2352x1568; color fundus photograph: 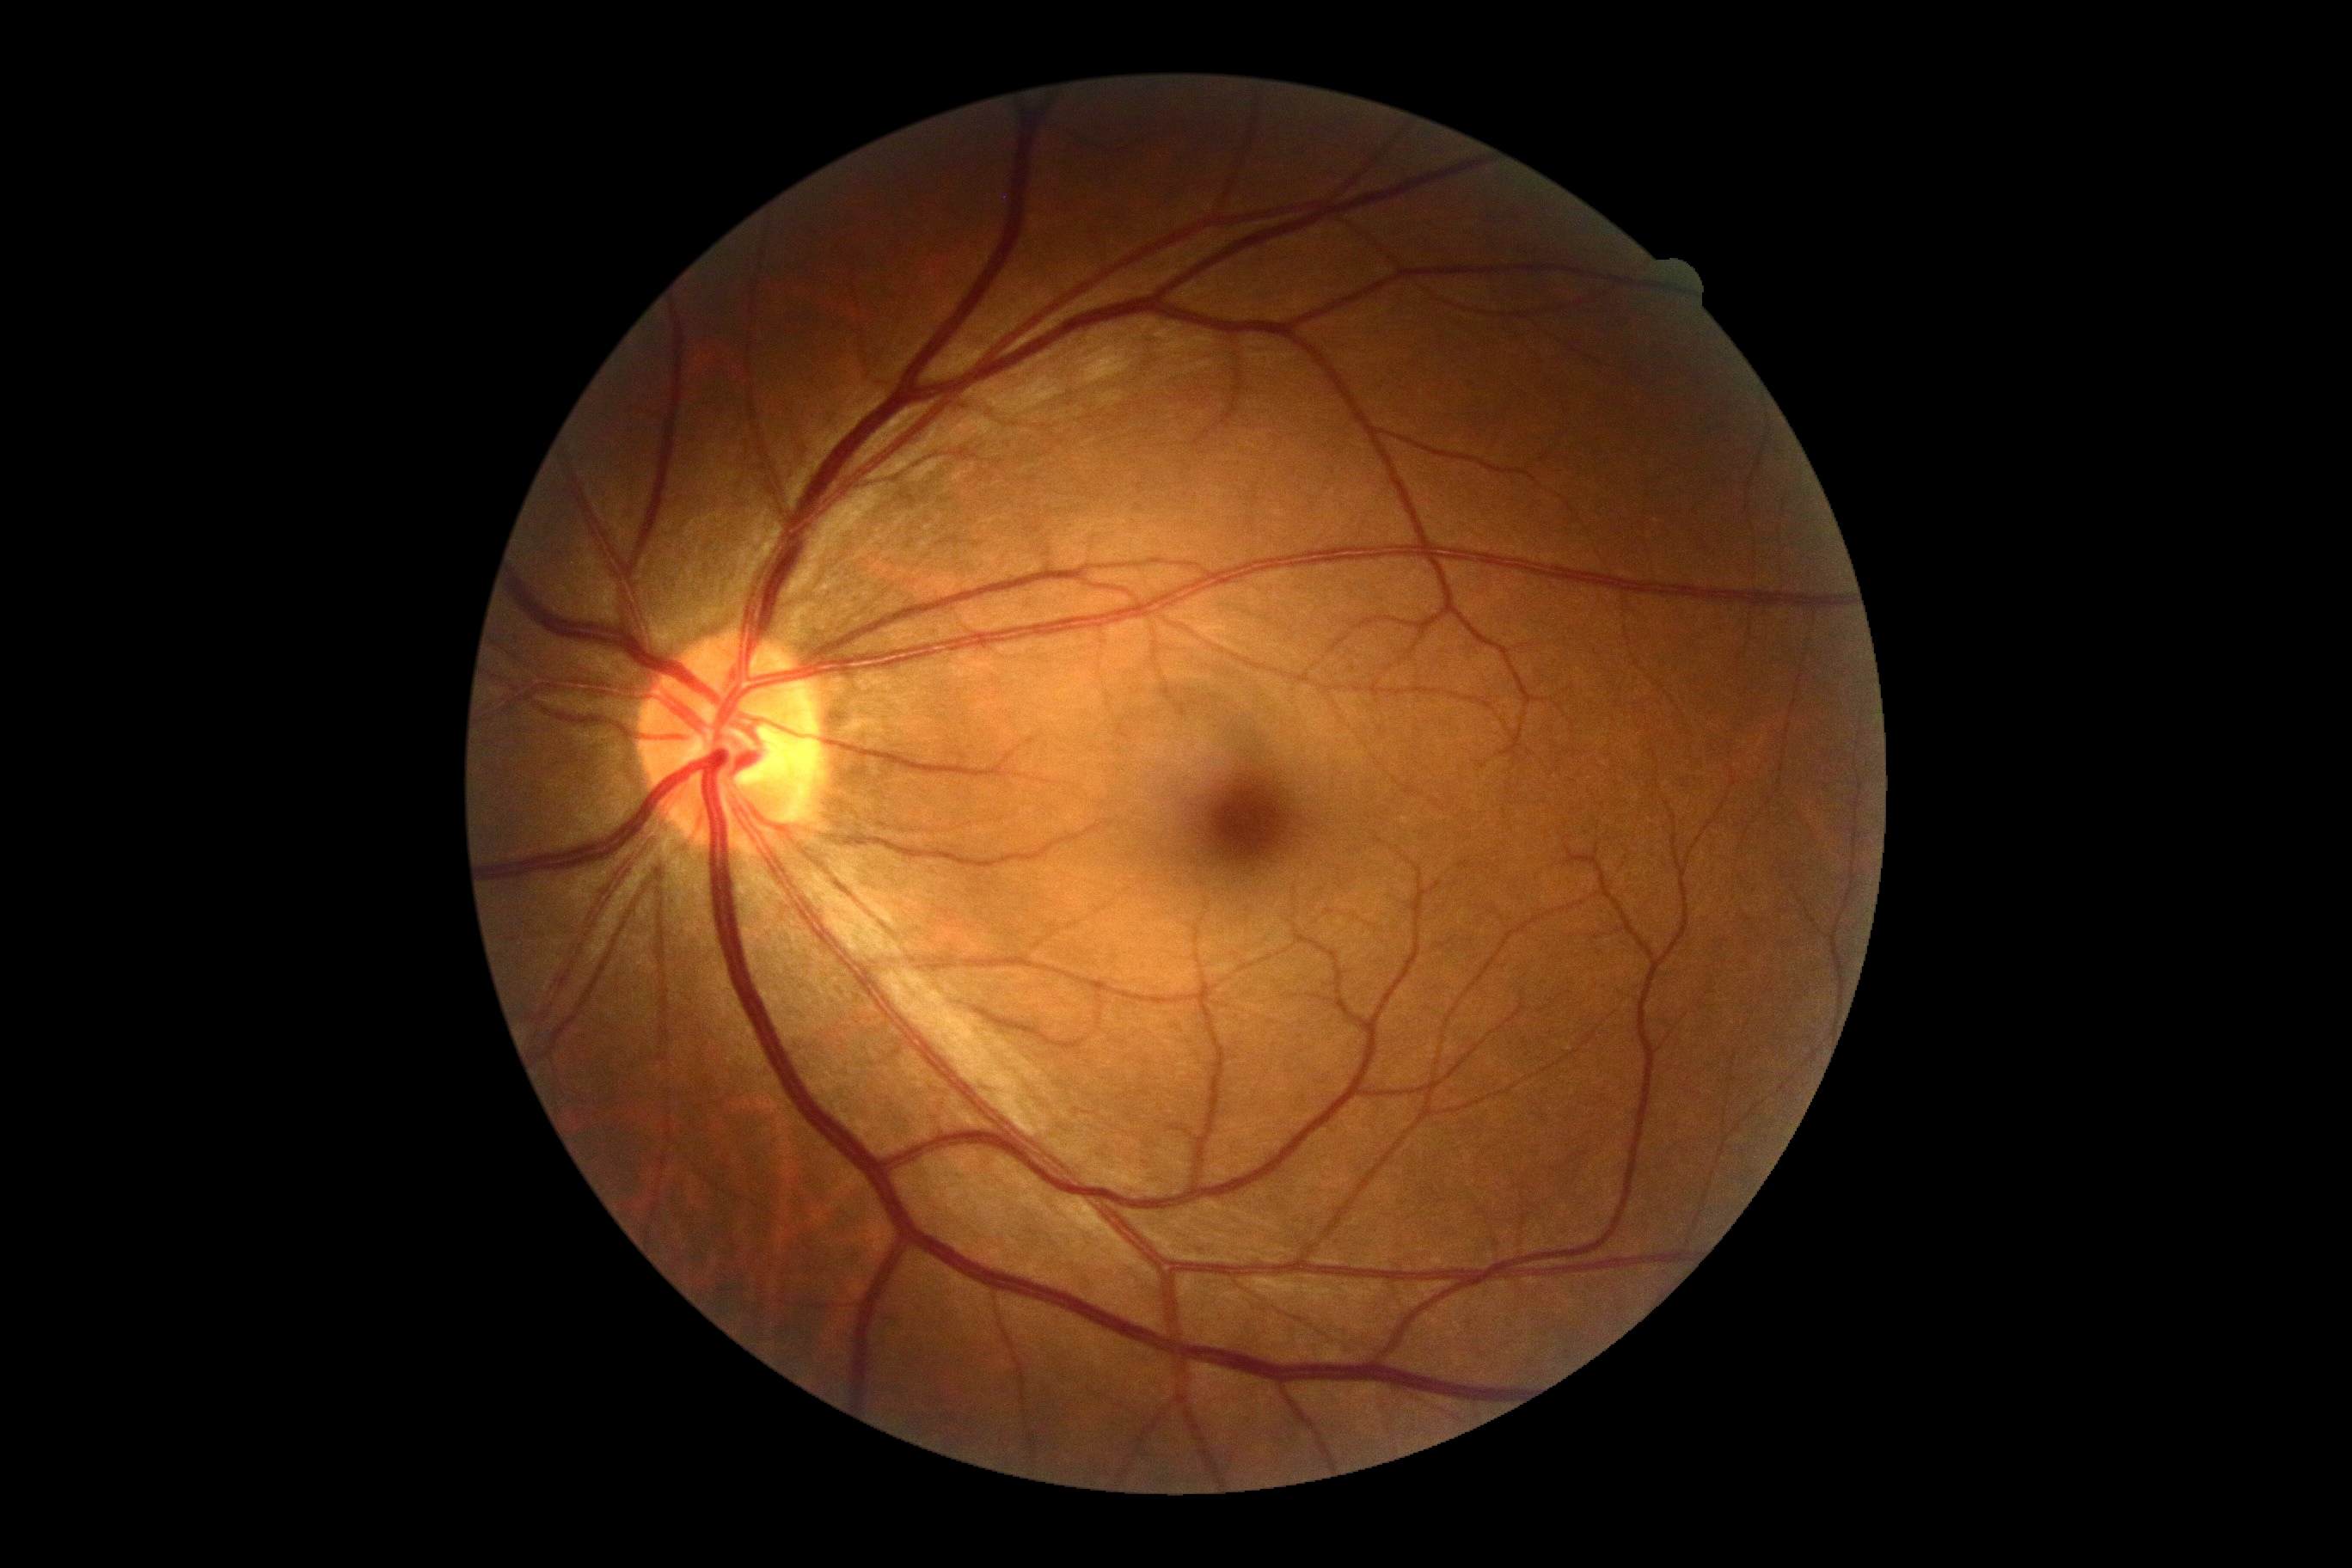 No apparent diabetic retinopathy.
DR stage: grade 0.